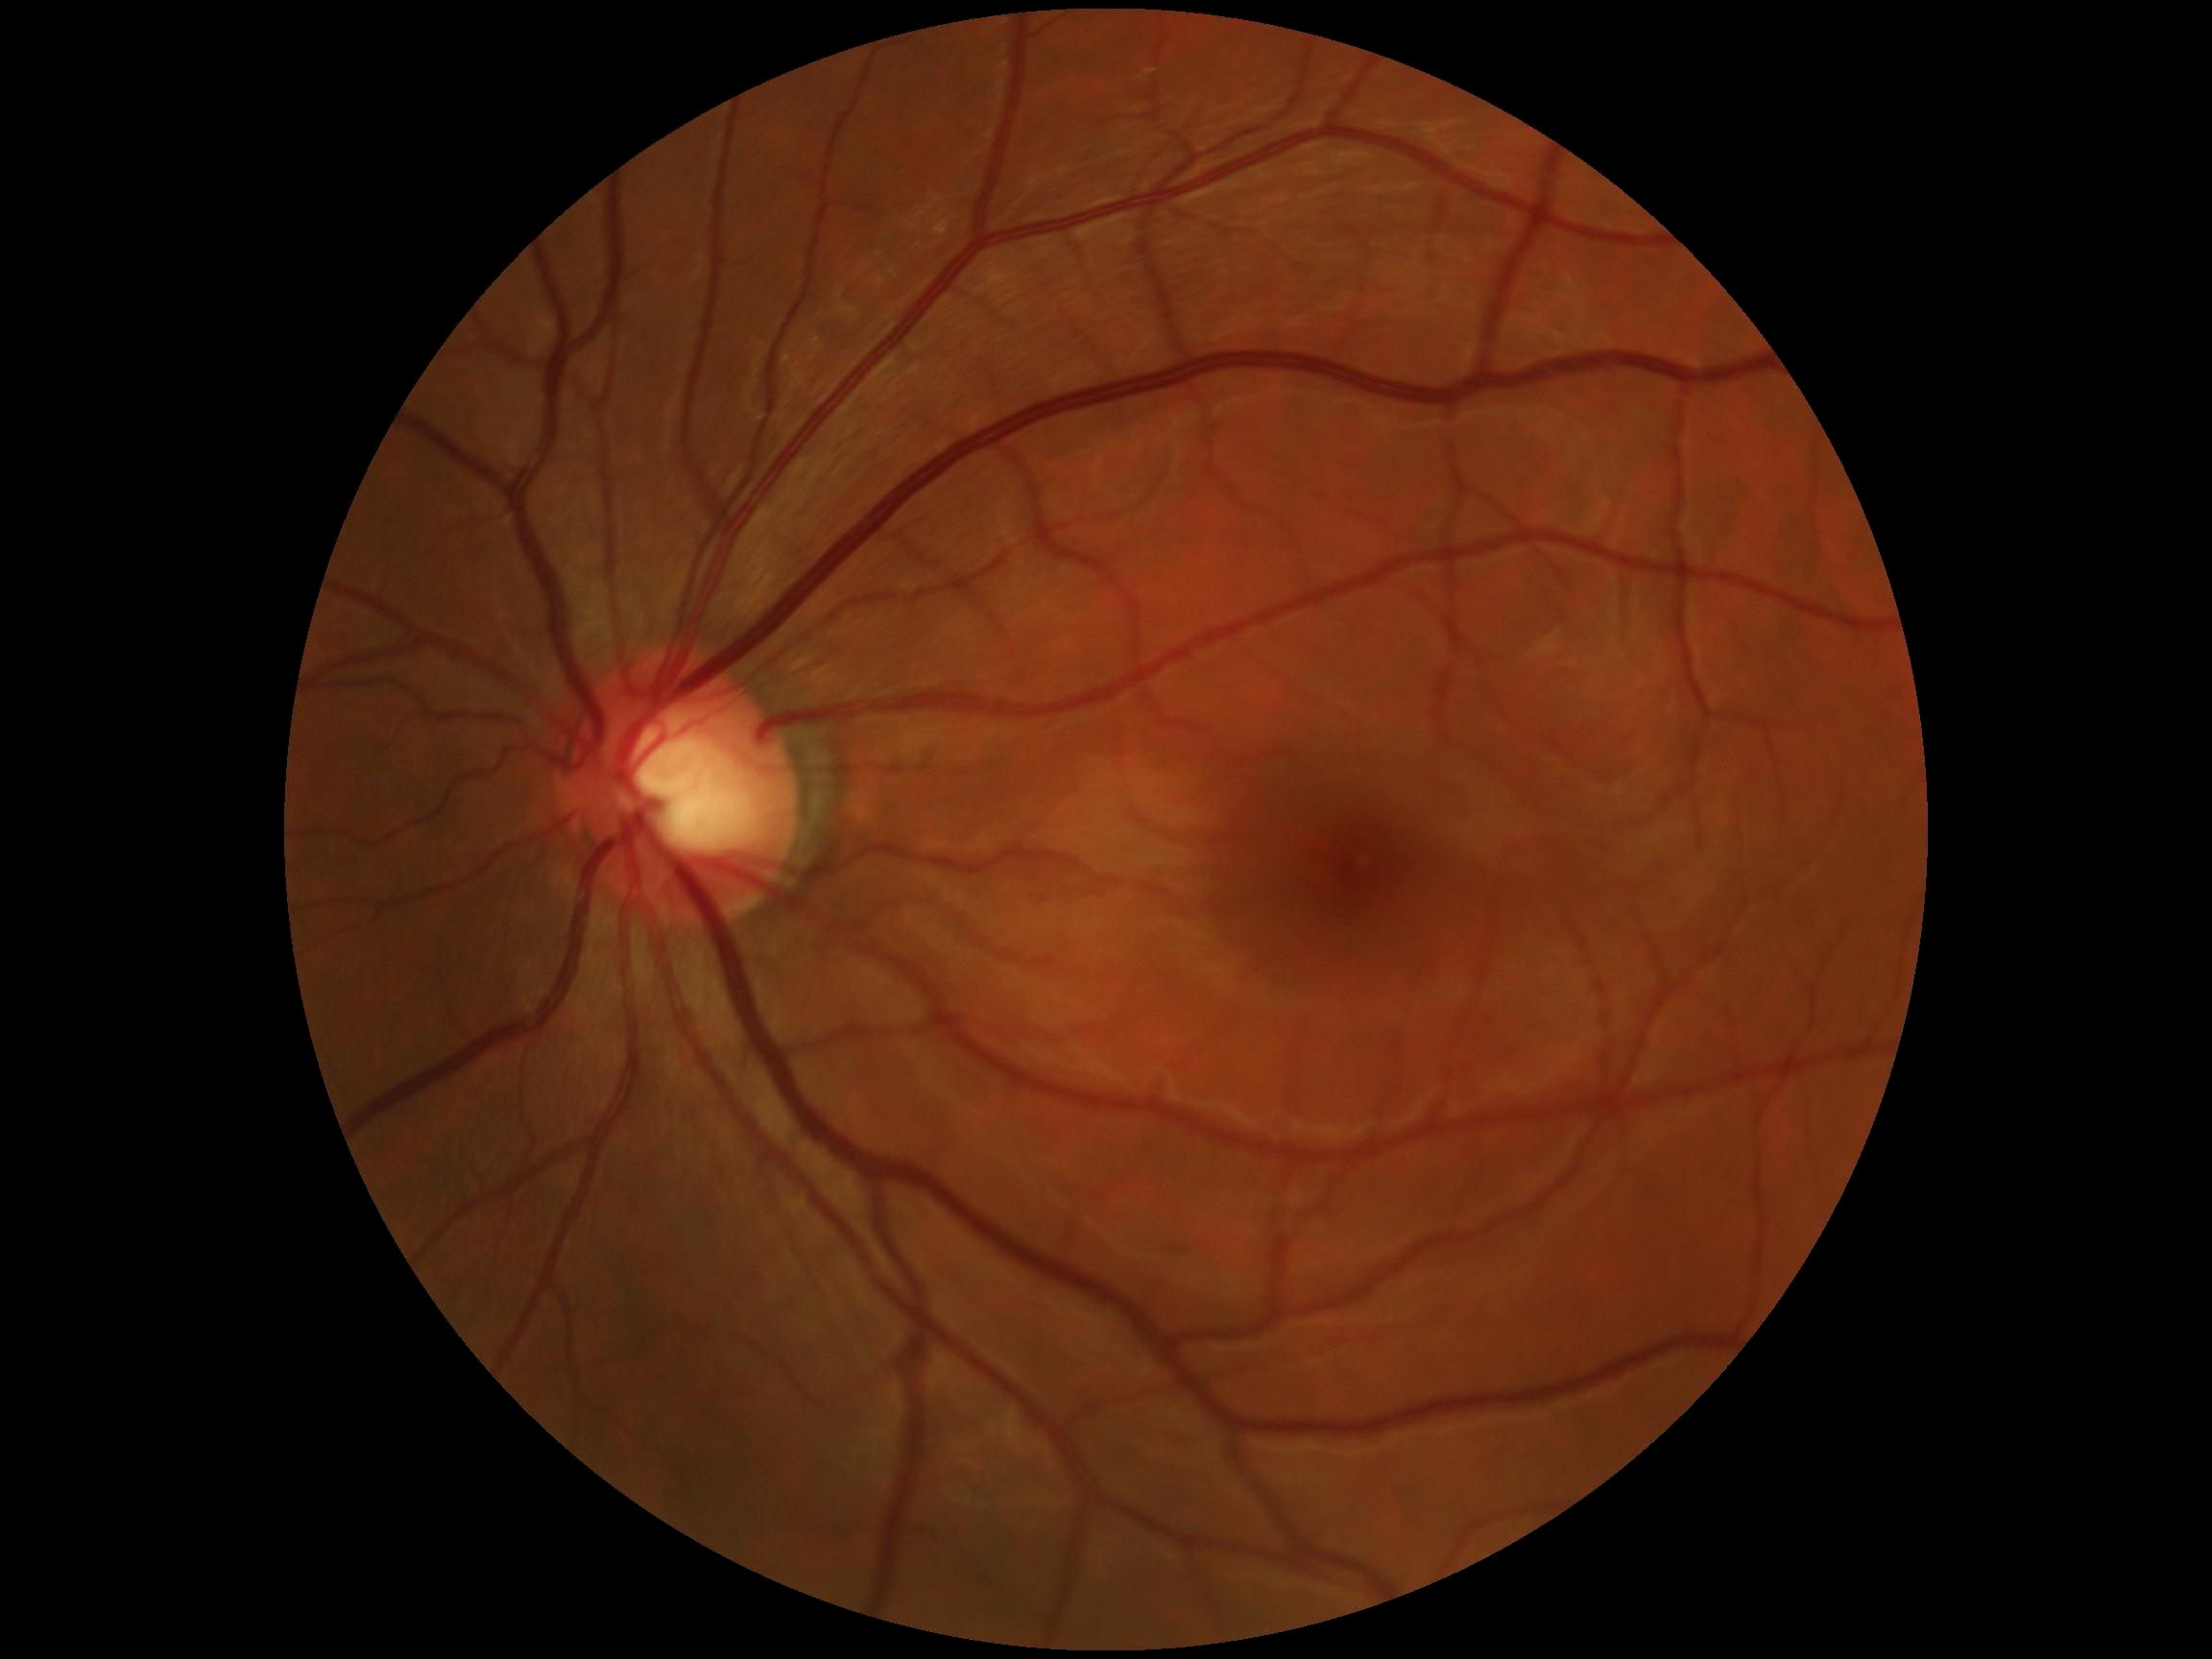
DR stage is 0. No apparent diabetic retinopathy.